848x848.
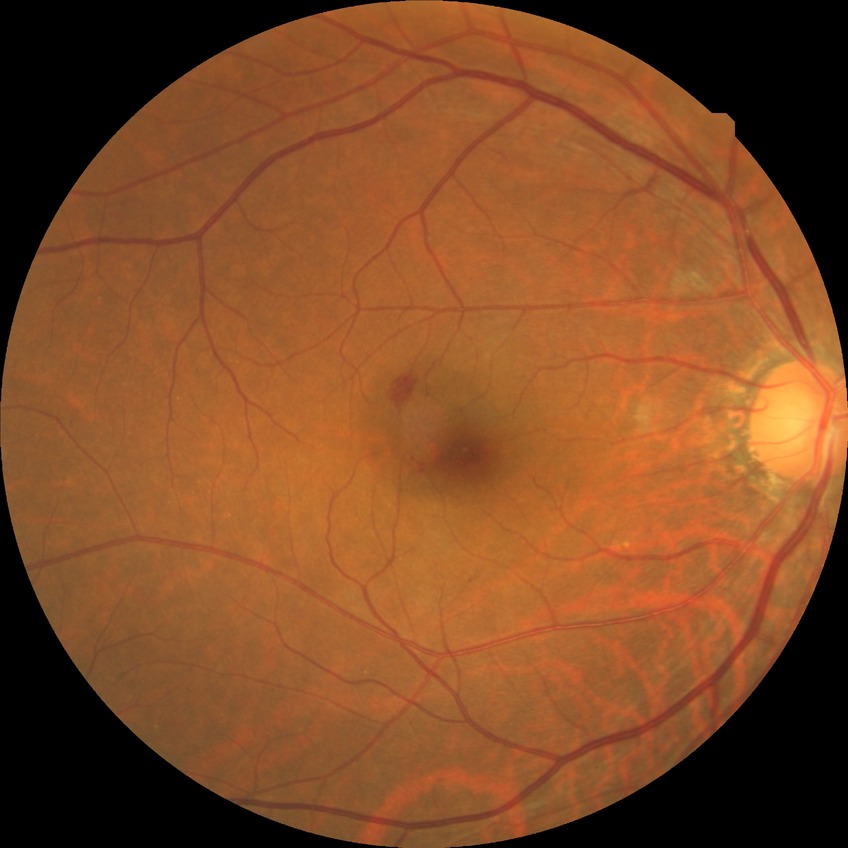 Davis grade: SDR